45° FOV:
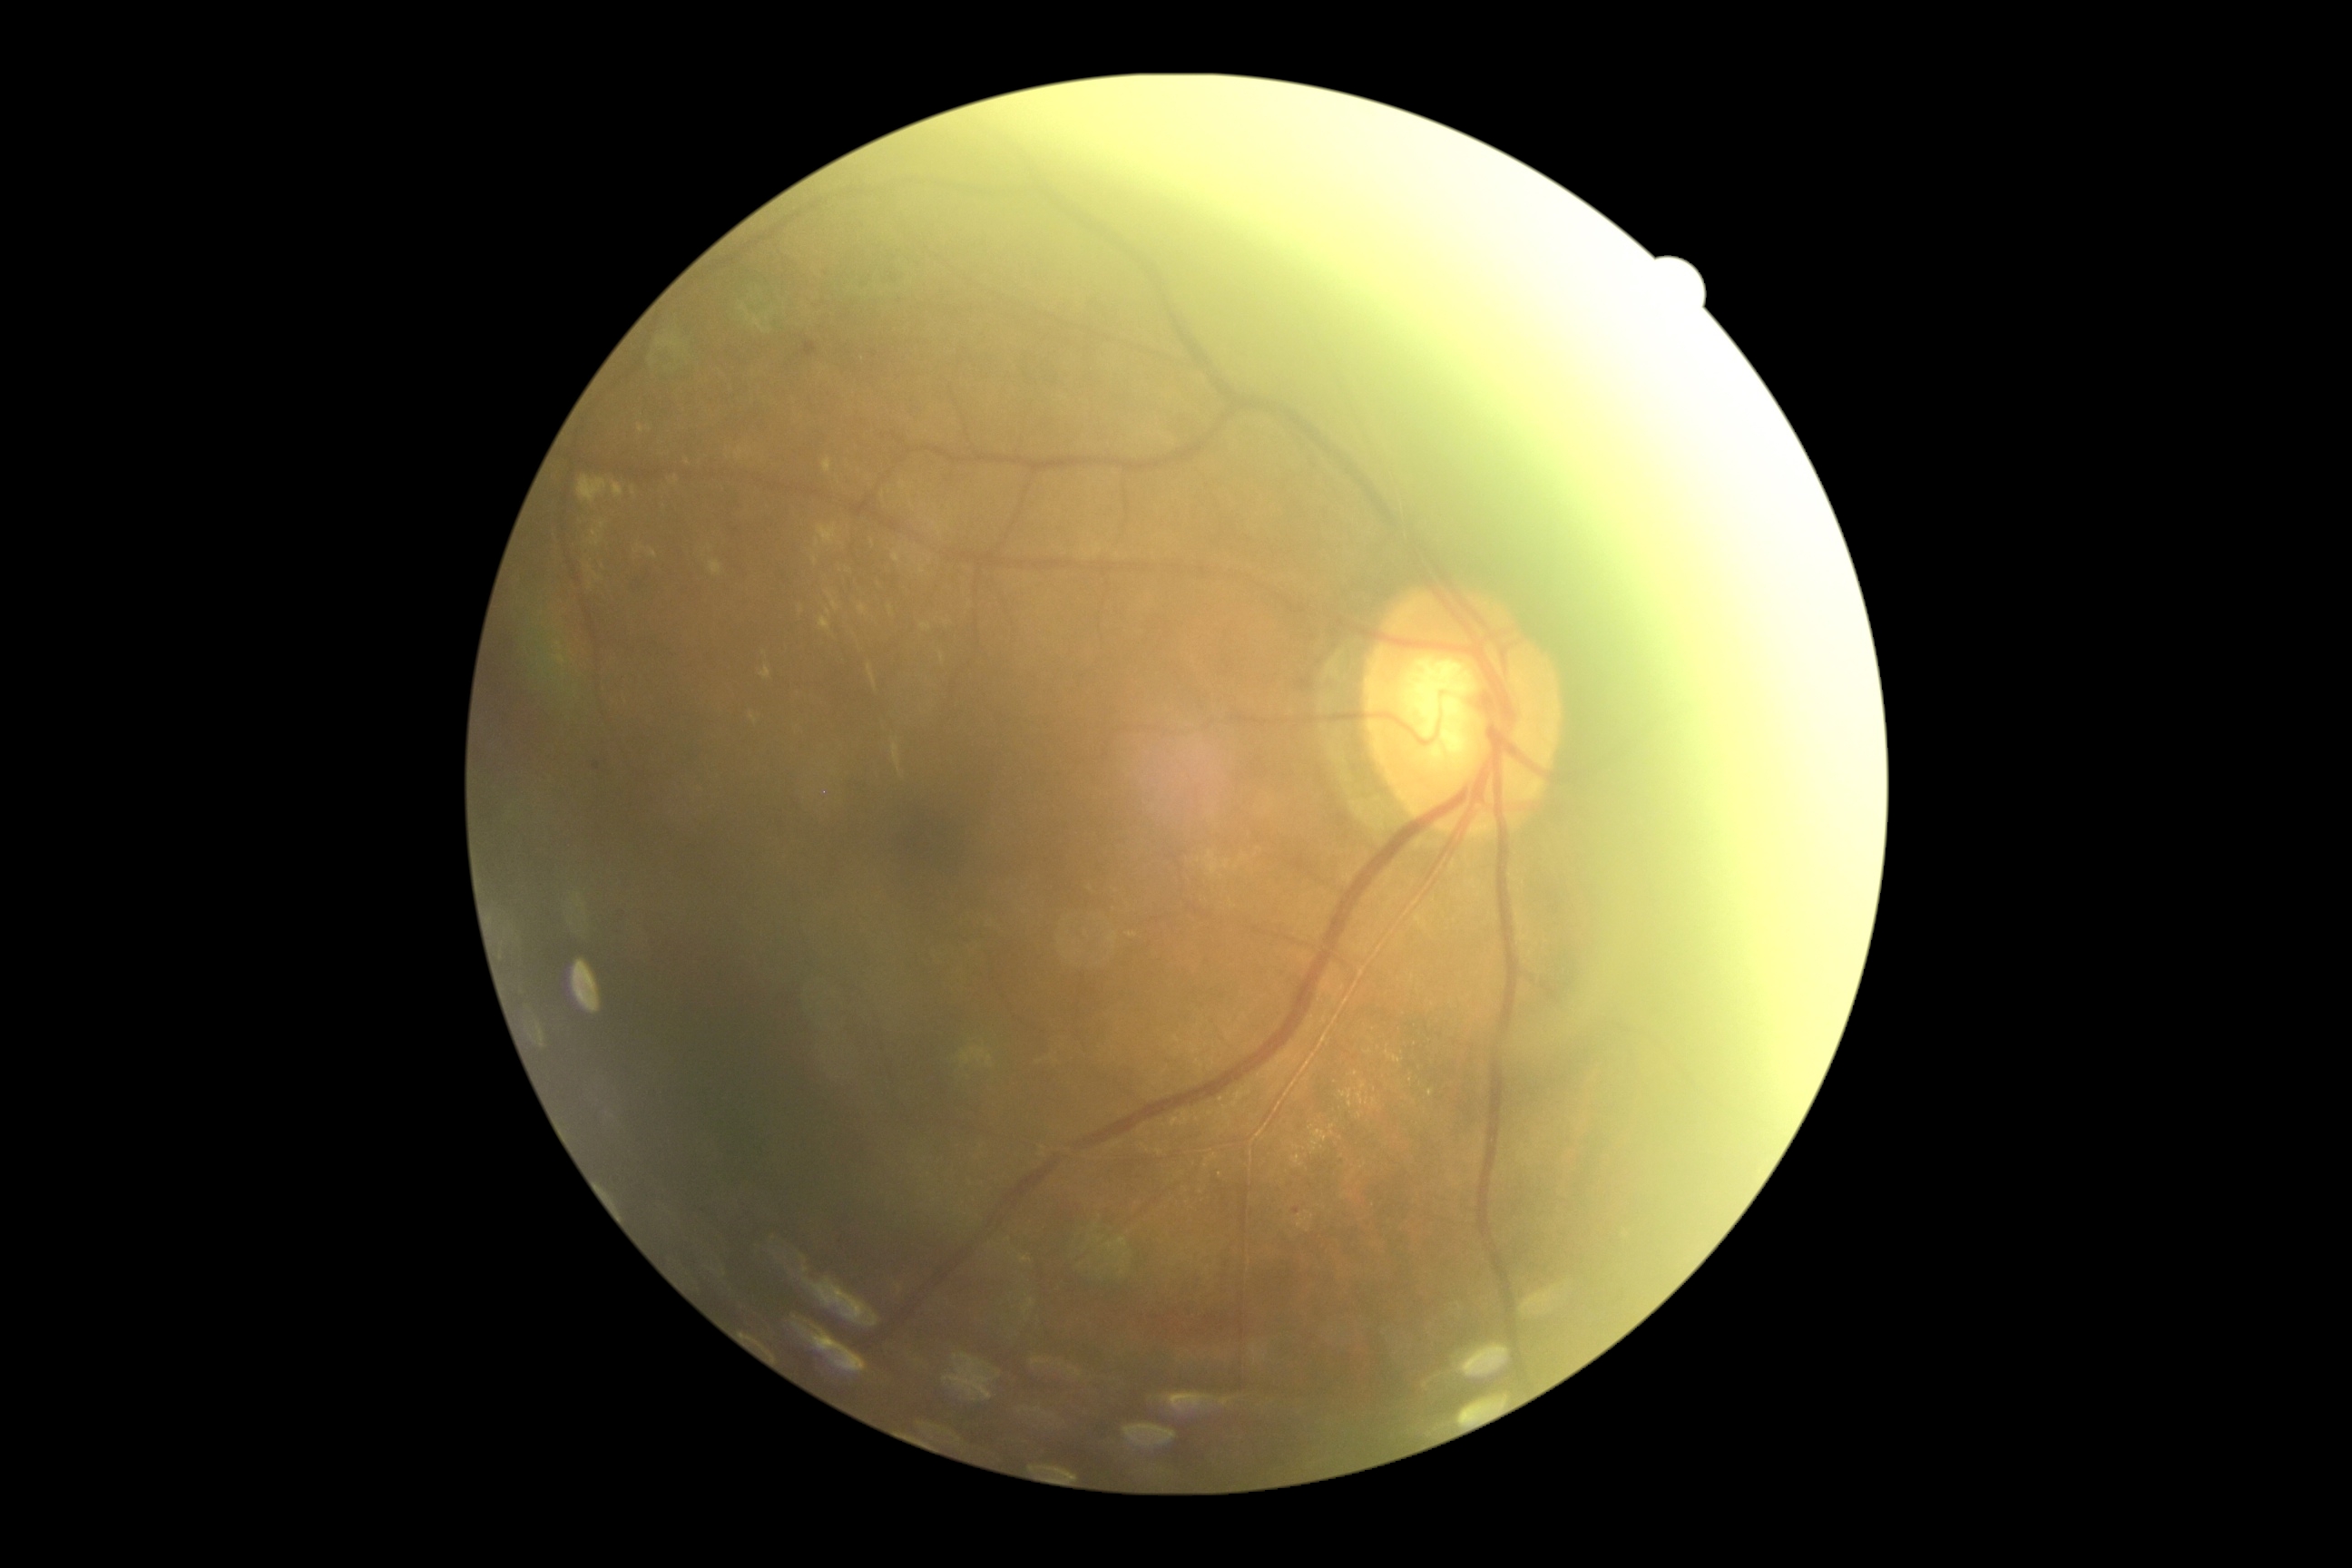
Diabetic retinopathy severity is moderate NPDR (grade 2).